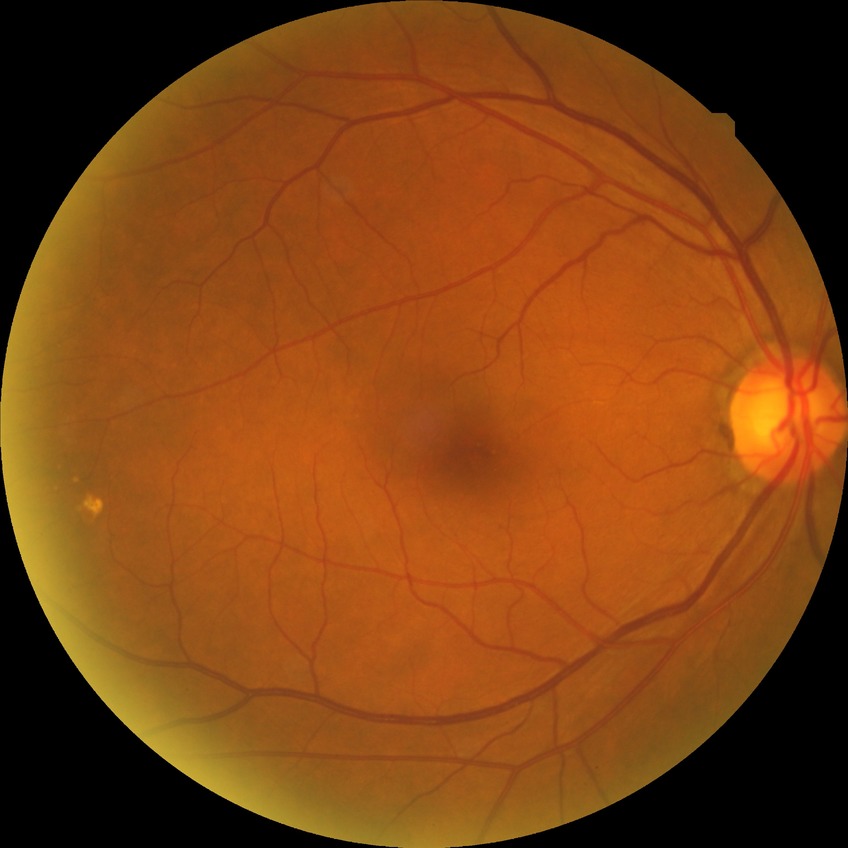

Assessment:
– diabetic retinopathy grade: no diabetic retinopathy